Color fundus photograph. Nonmydriatic. NIDEK AFC-230: 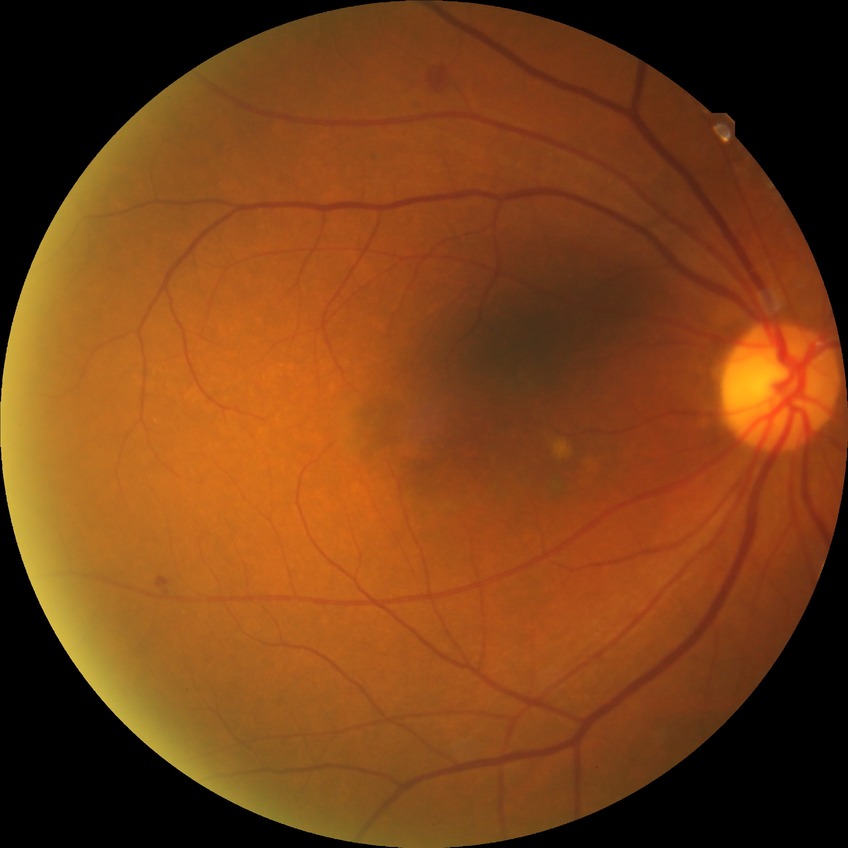 diabetic retinopathy (DR): SDR (simple diabetic retinopathy).